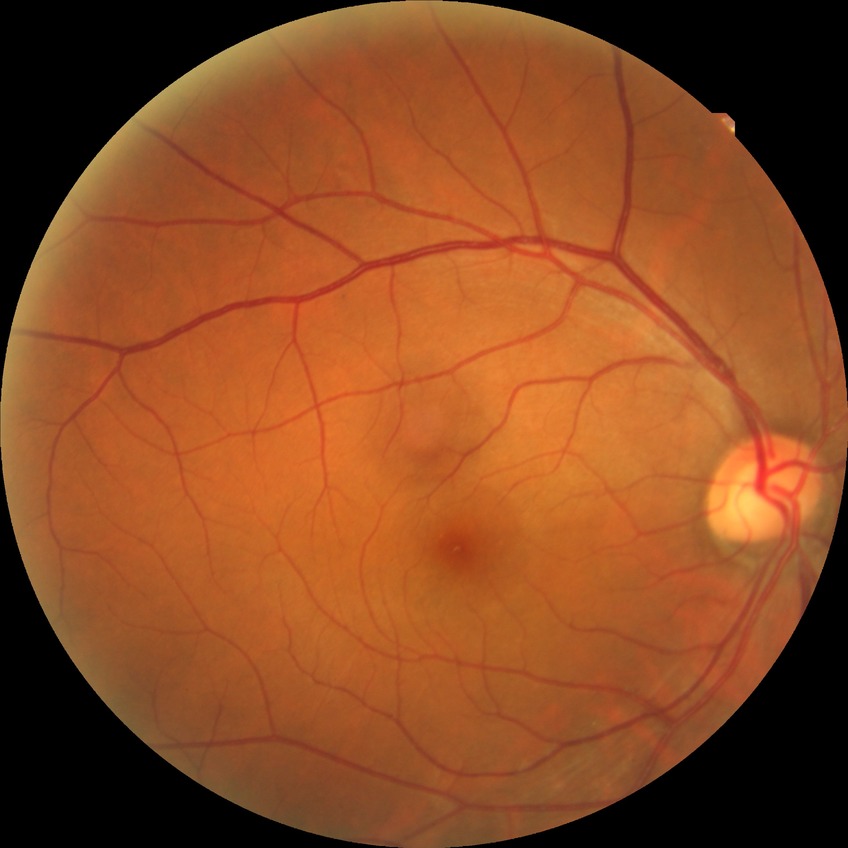

  davis_grade: no diabetic retinopathy (NDR)